FOV: 45 degrees. Color fundus photograph. 848 x 848 pixels:
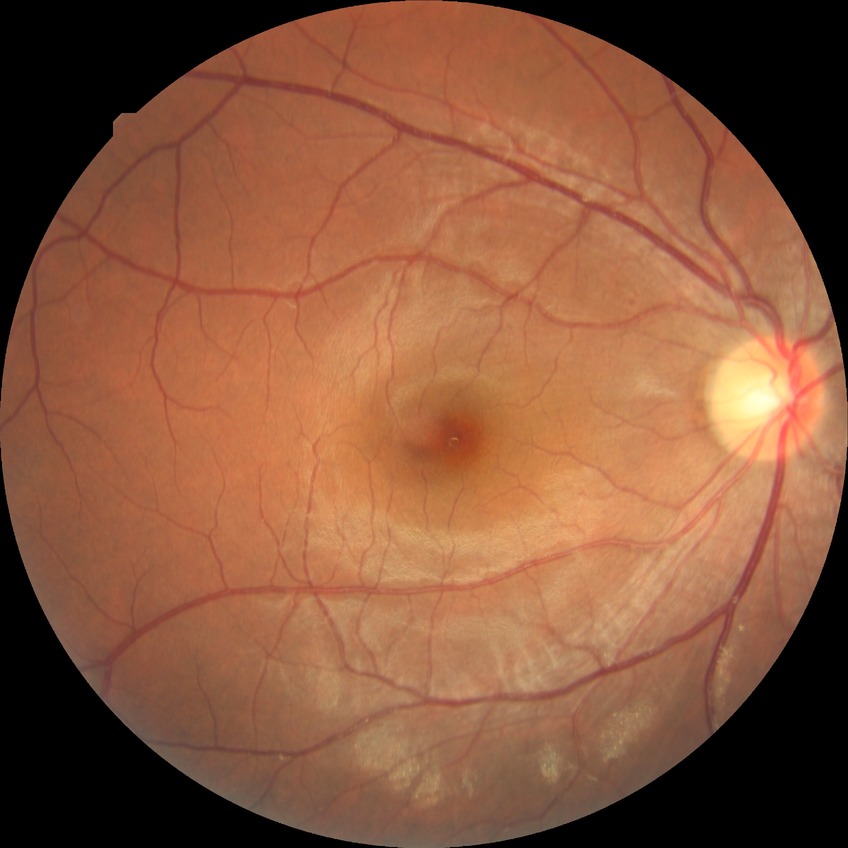

davis_grade: NDR (no diabetic retinopathy)